FOV: 45 degrees. CFP. 2212x1659px: 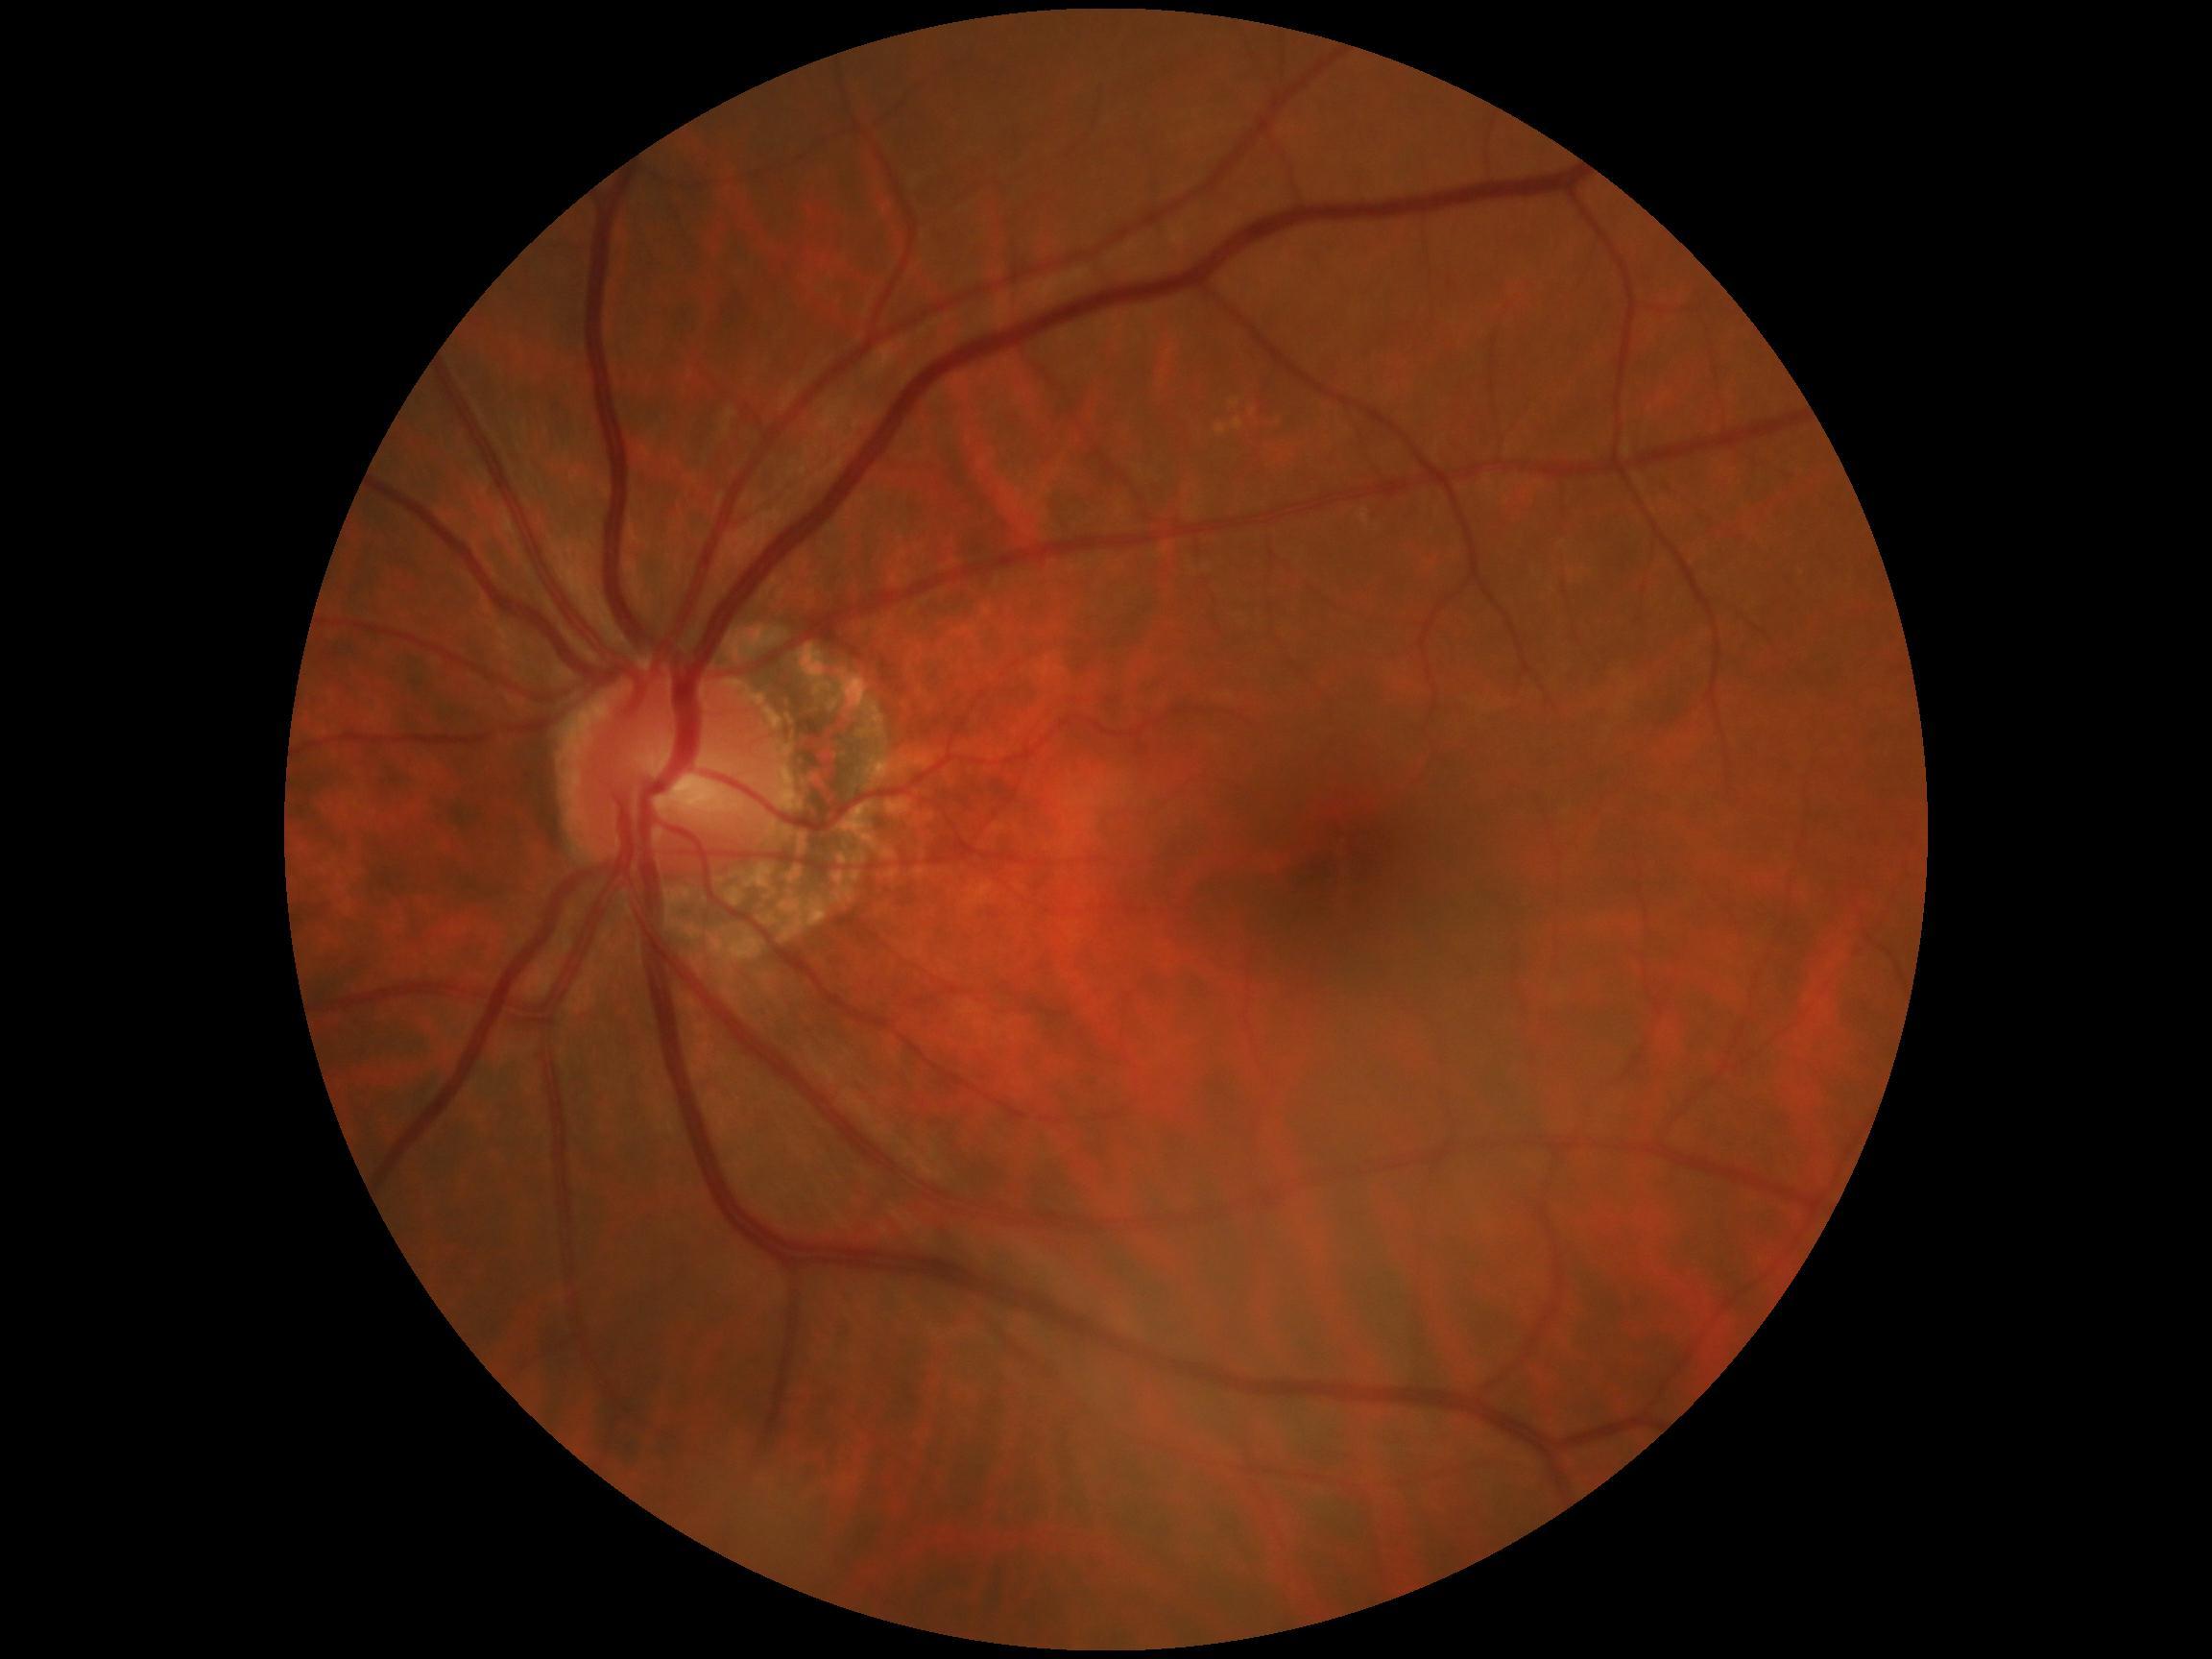
Annotations:
– DR impression — no DR findings
– diabetic retinopathy grade — 0